512 by 512 pixels. Color fundus image: 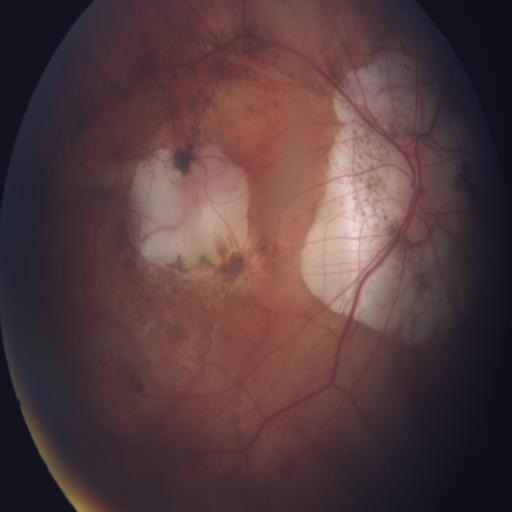

Abnormalities: MYA (myopia).